Graded on the modified Davis scale
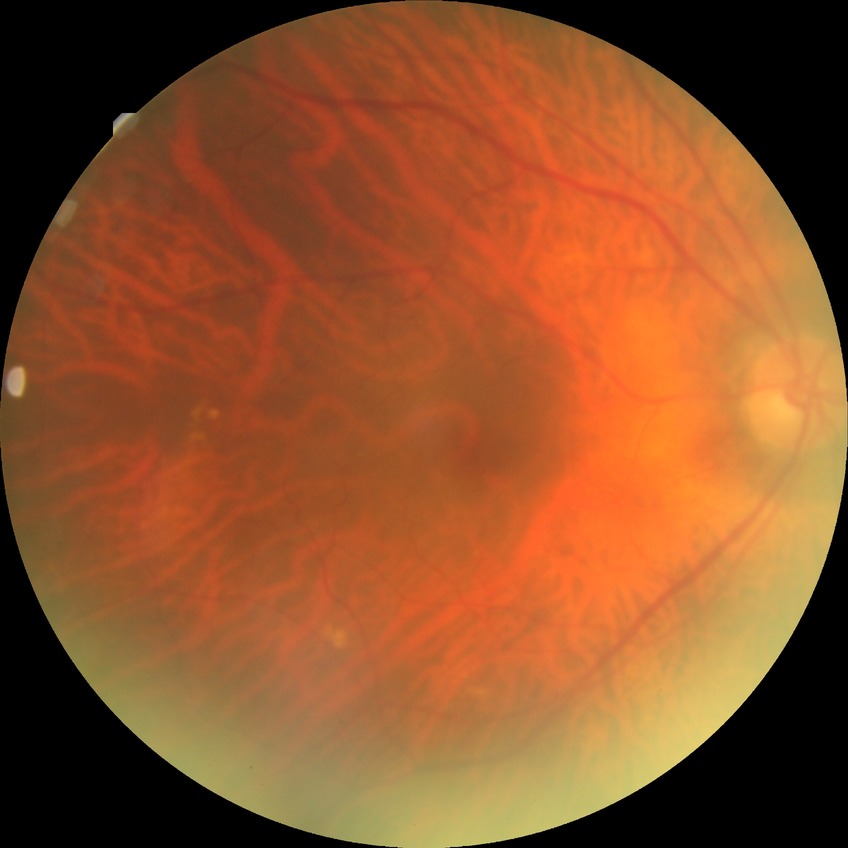
Davis stage is NDR.